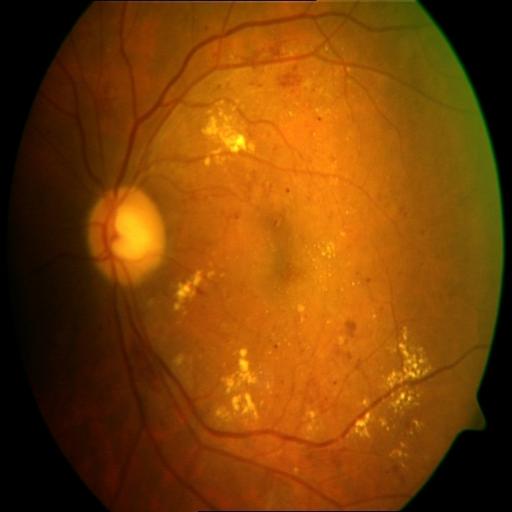 Abnormalities: exudation (EDN); hemorrhagic retinopathy (HR).